Retinal fundus photograph:
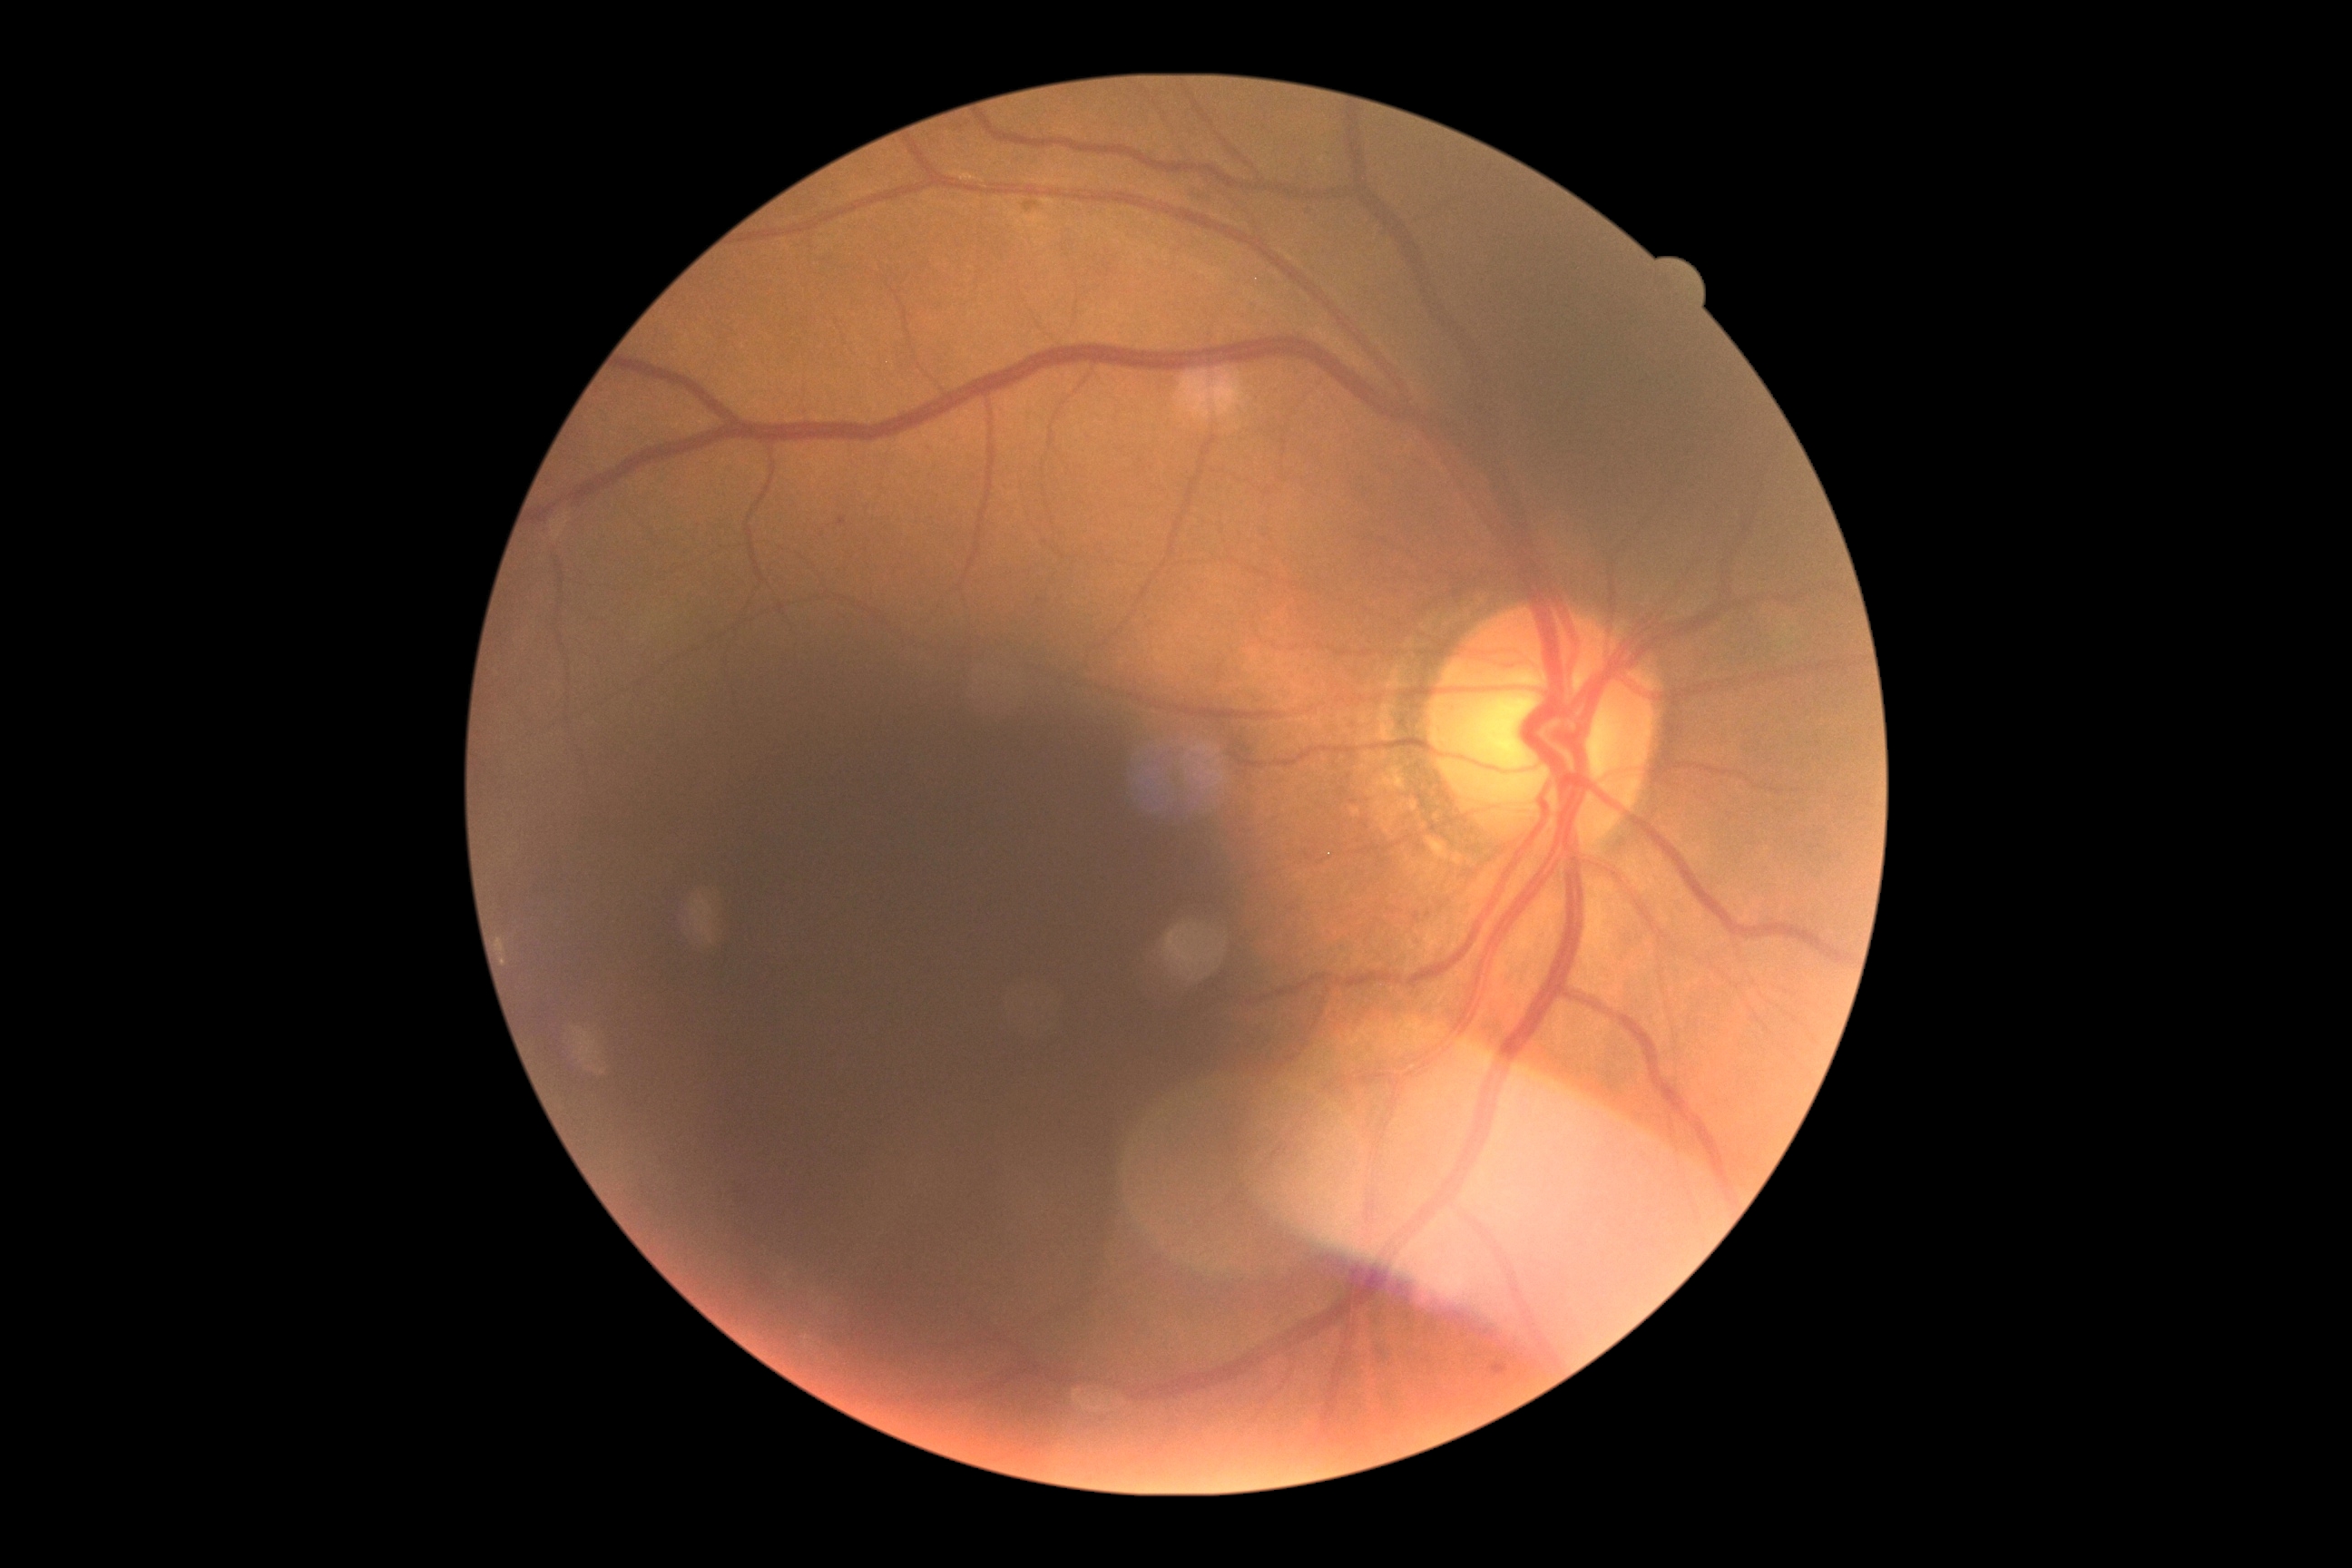
Retinopathy grade: mild NPDR (1).